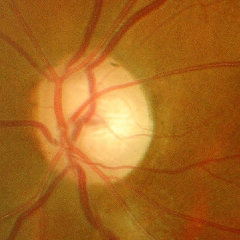

This fundus photograph shows advanced glaucoma.